Nonmydriatic fundus photograph:
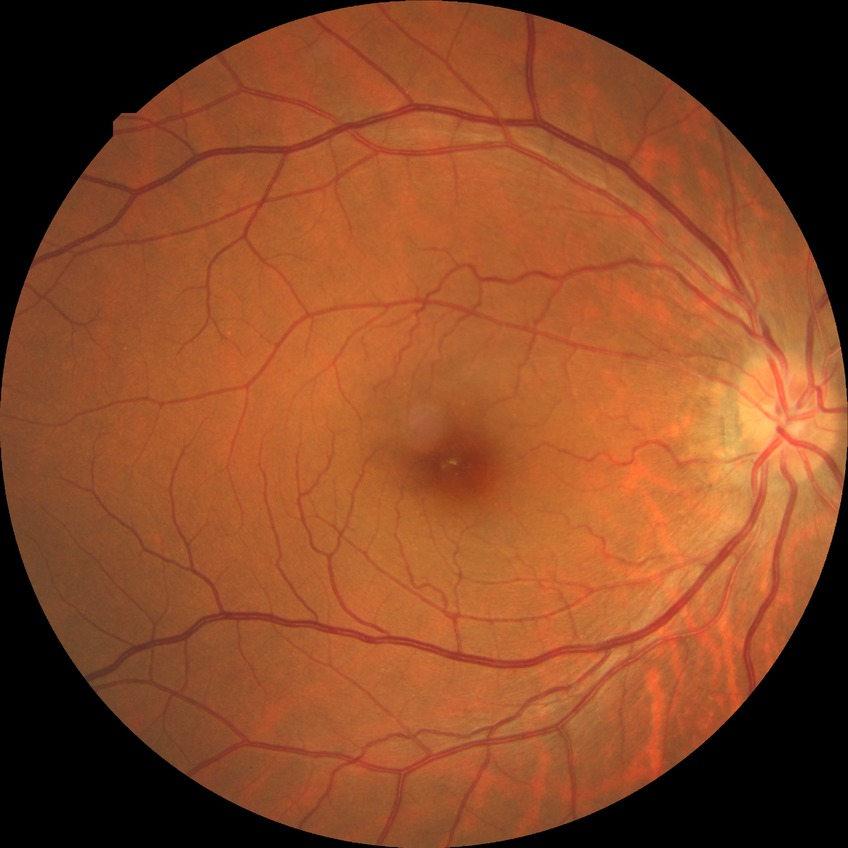 davis_grade: NDR (no diabetic retinopathy)